2184x1690px · color fundus photograph.
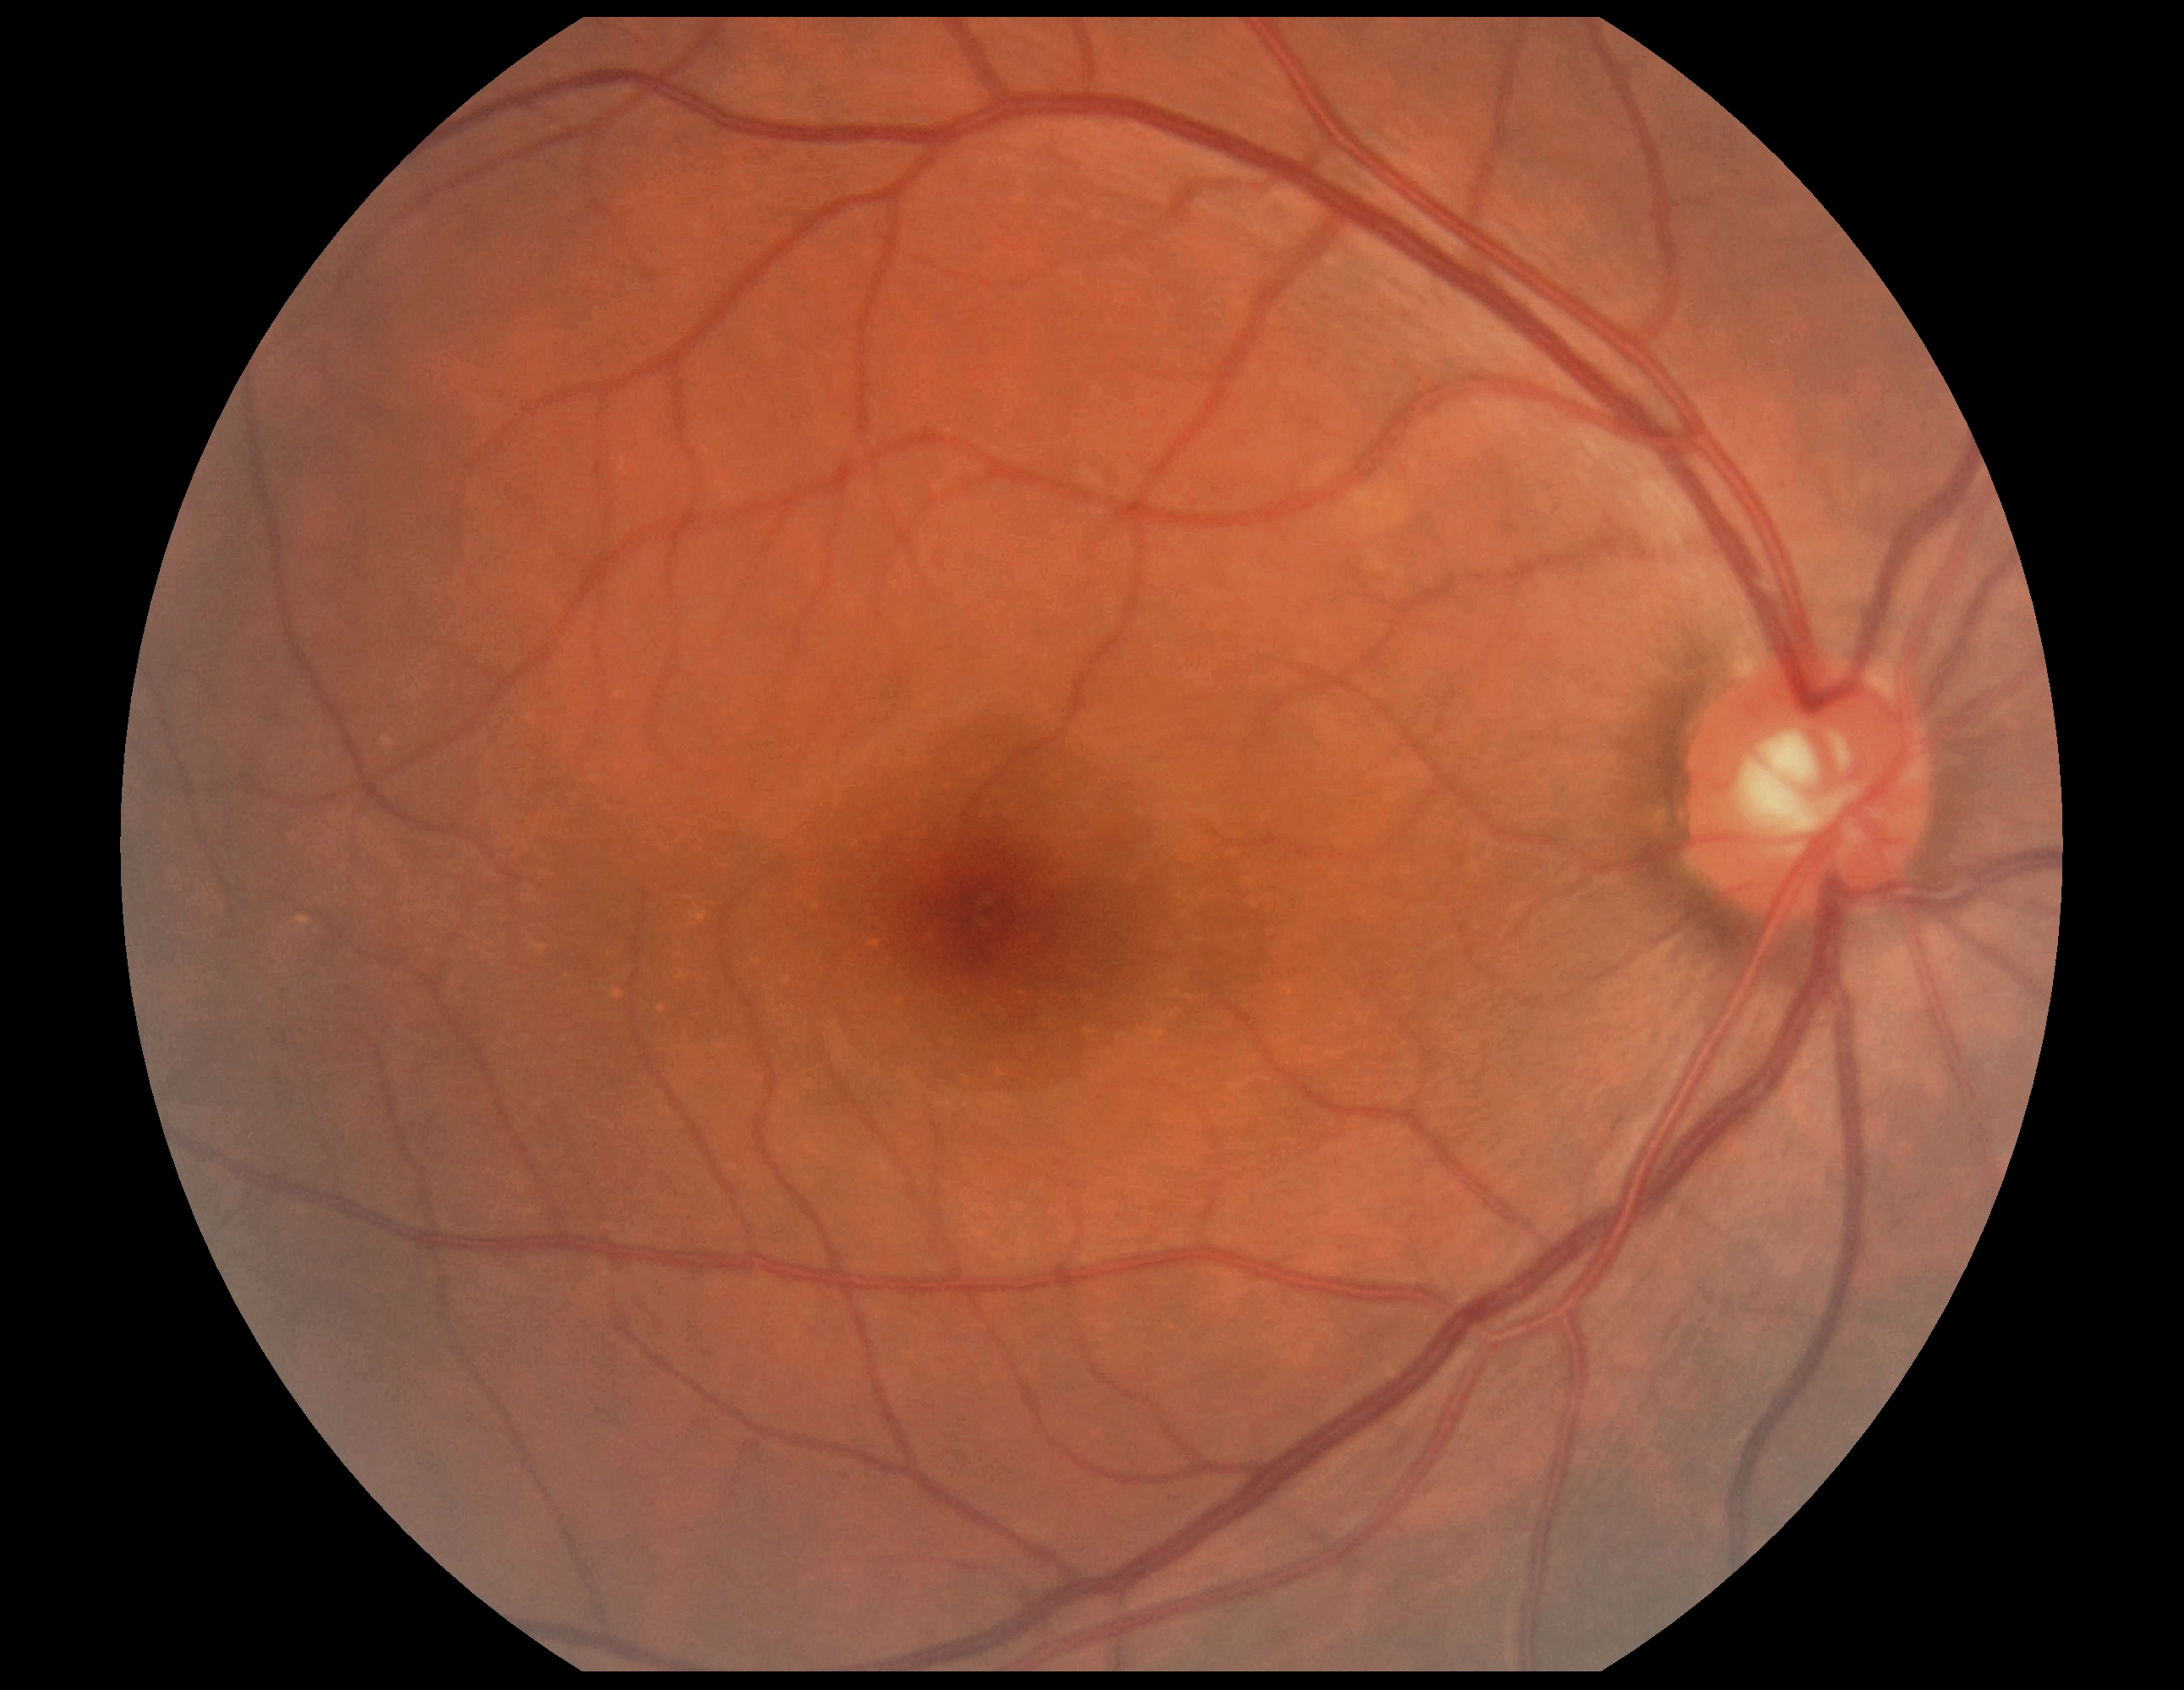

Diabetic retinopathy grade: 0/4. No diabetic retinal disease findings.